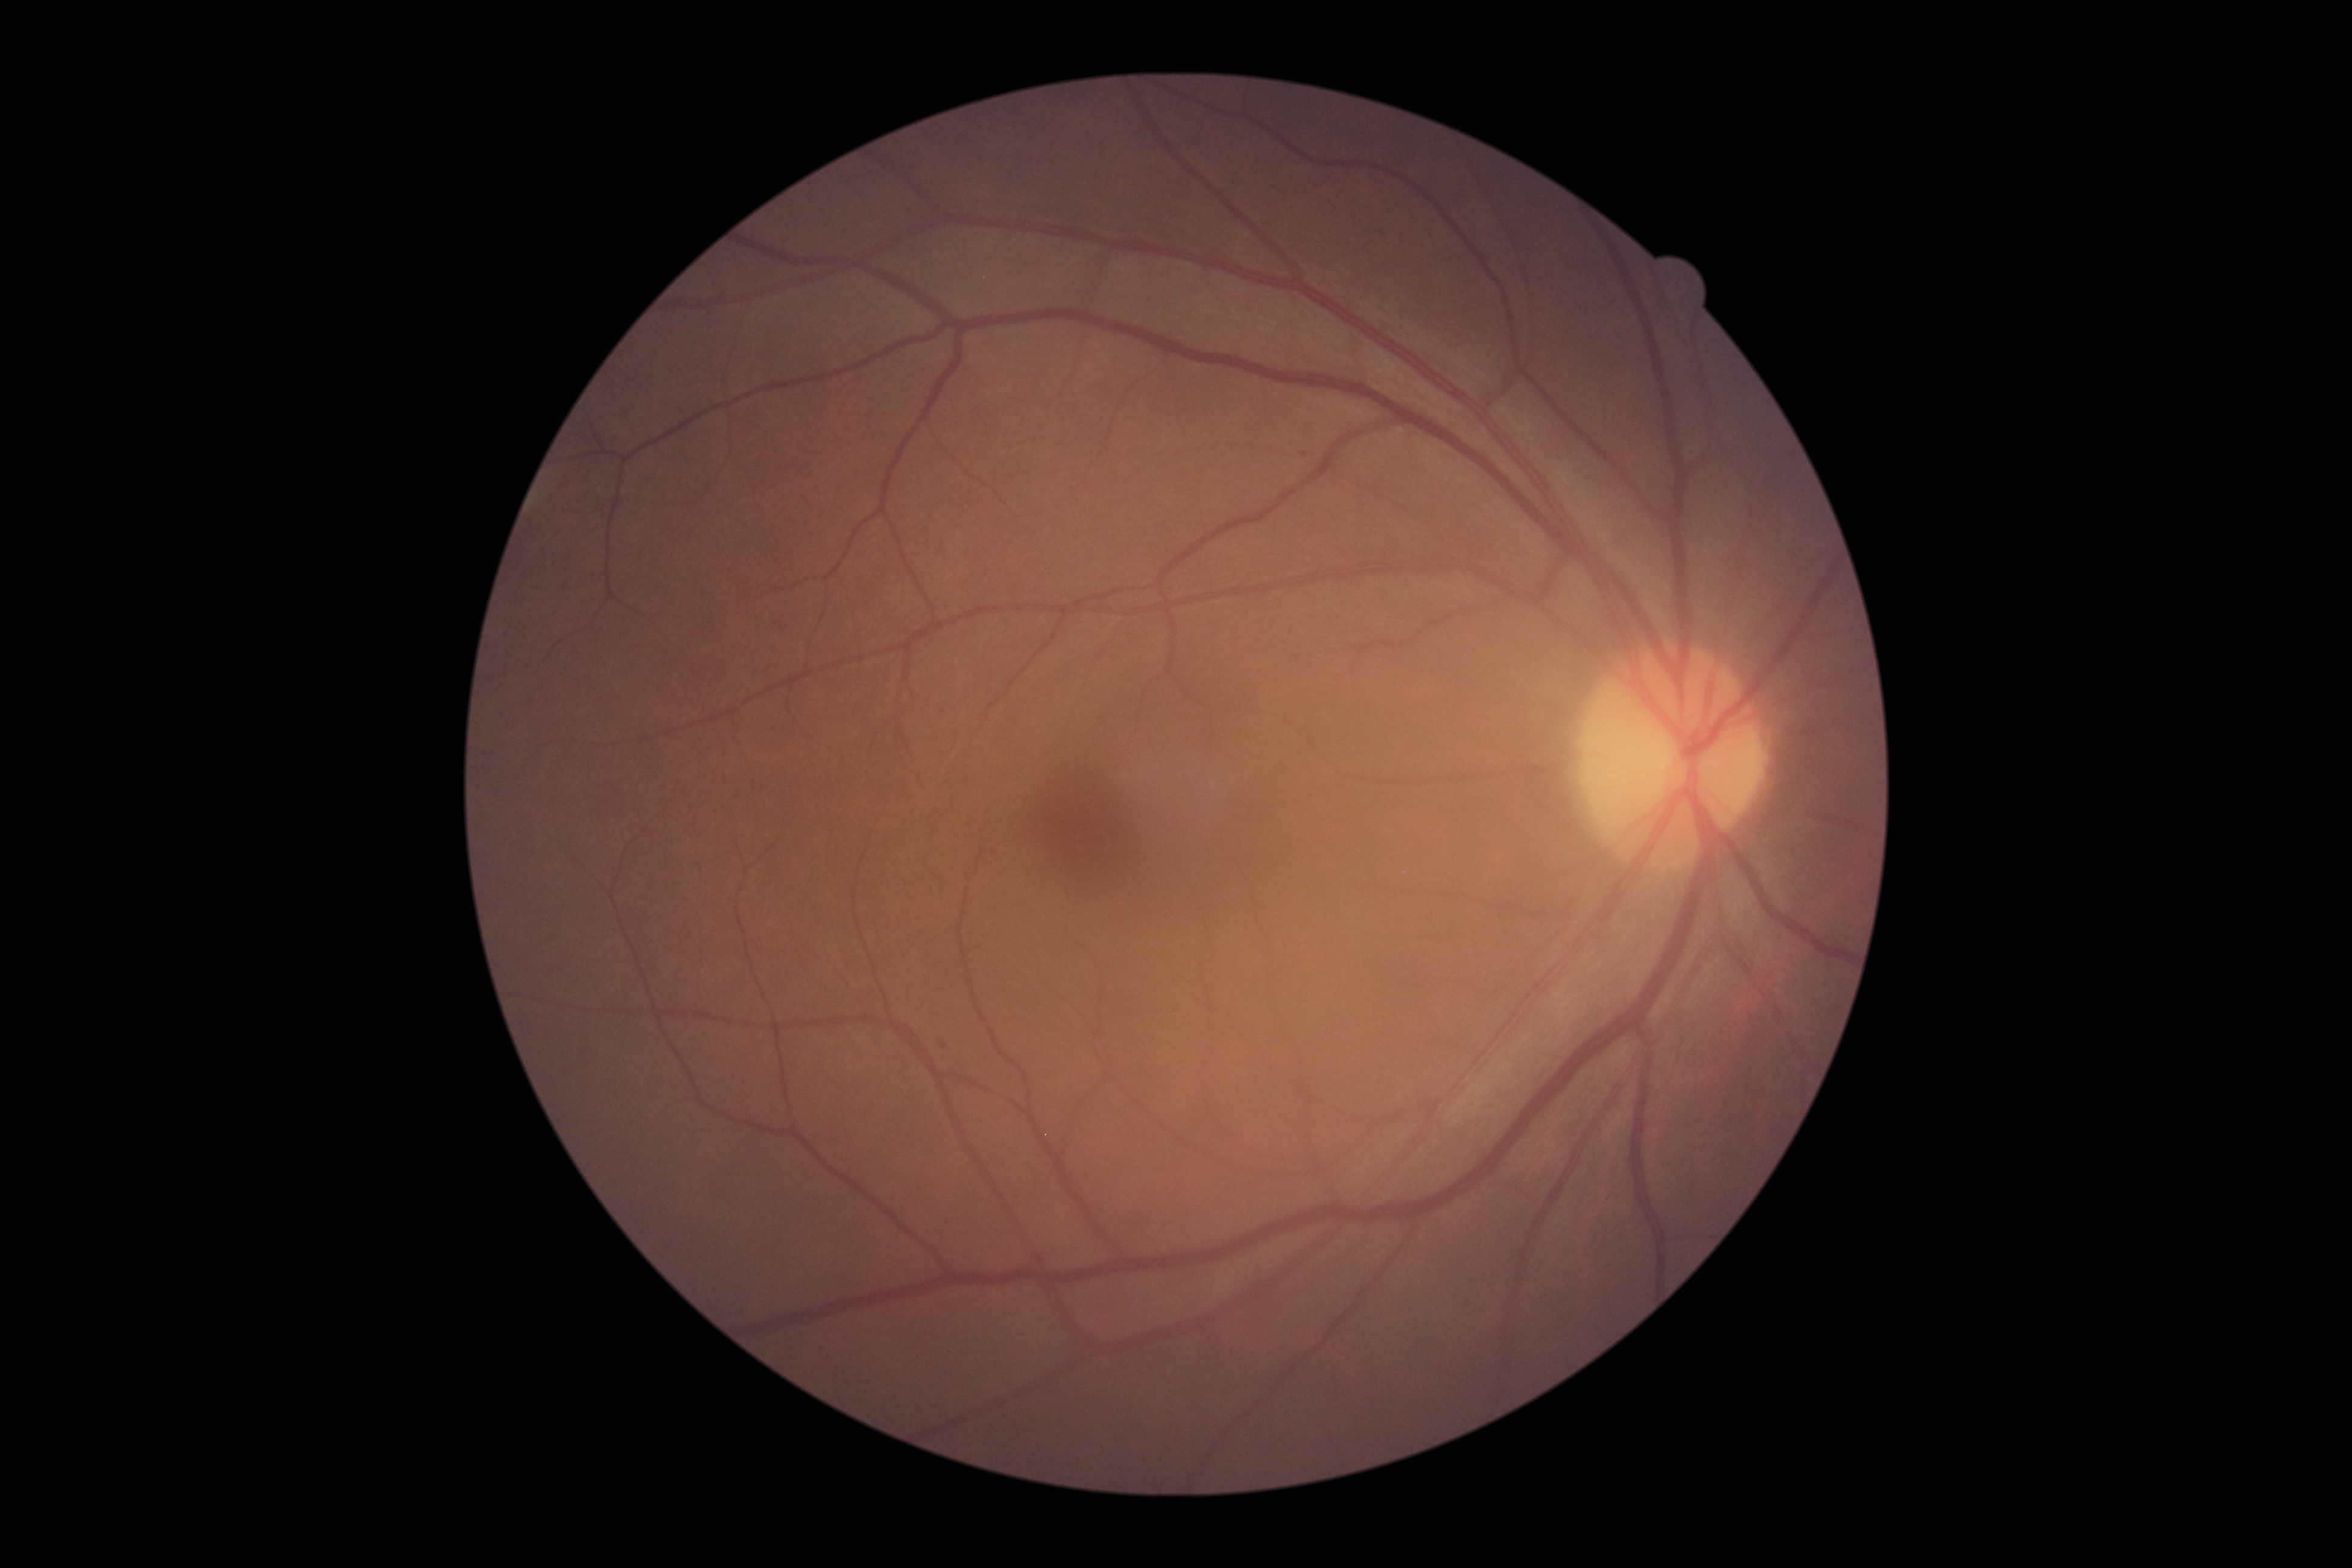

Findings:
• DR severity — mild NPDR (grade 1)